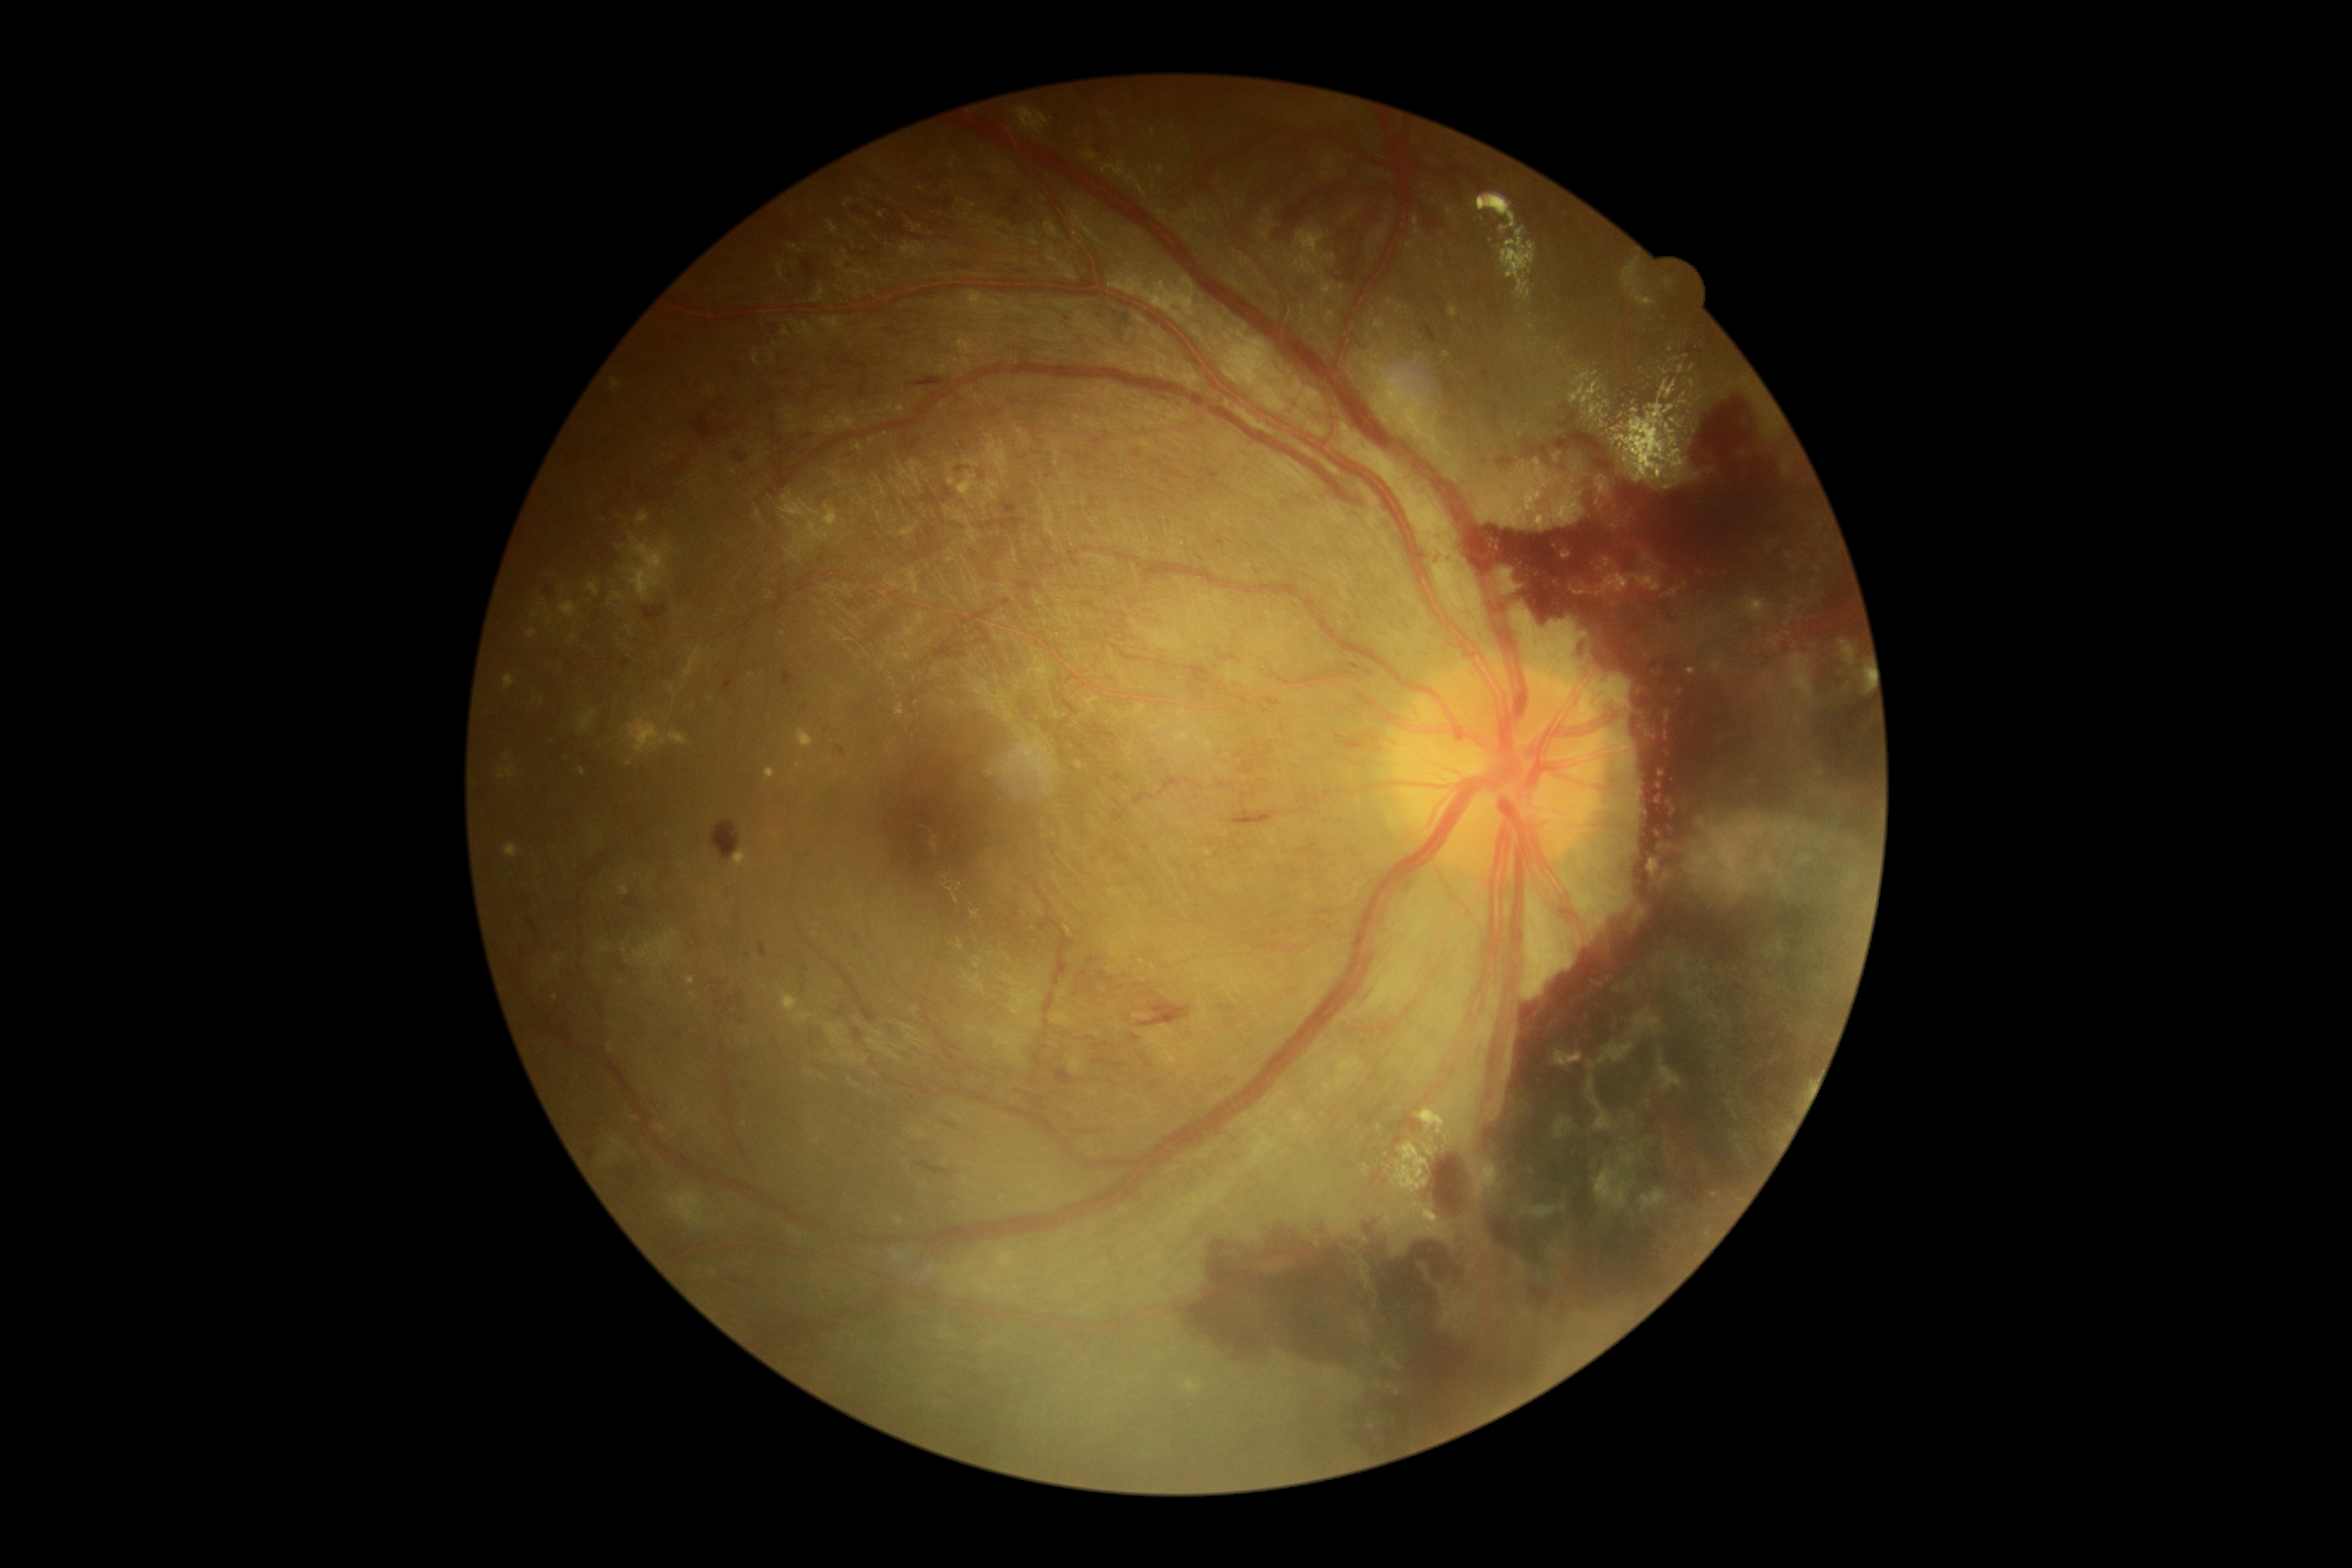

DR is PDR (grade 4) — neovascularization and/or vitreous/pre-retinal hemorrhage.